45° FOV. NIDEK AFC-230. 848 by 848 pixels. Posterior pole photograph. No pharmacologic dilation.
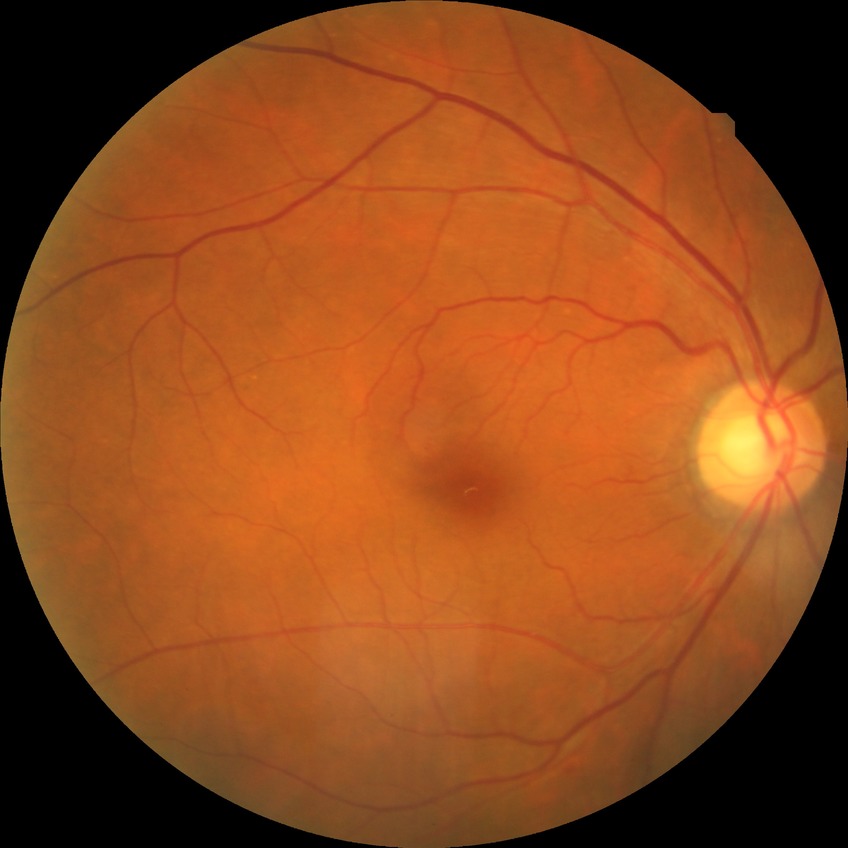

{"davis_grade": "SDR"}